Retinal fundus photograph: 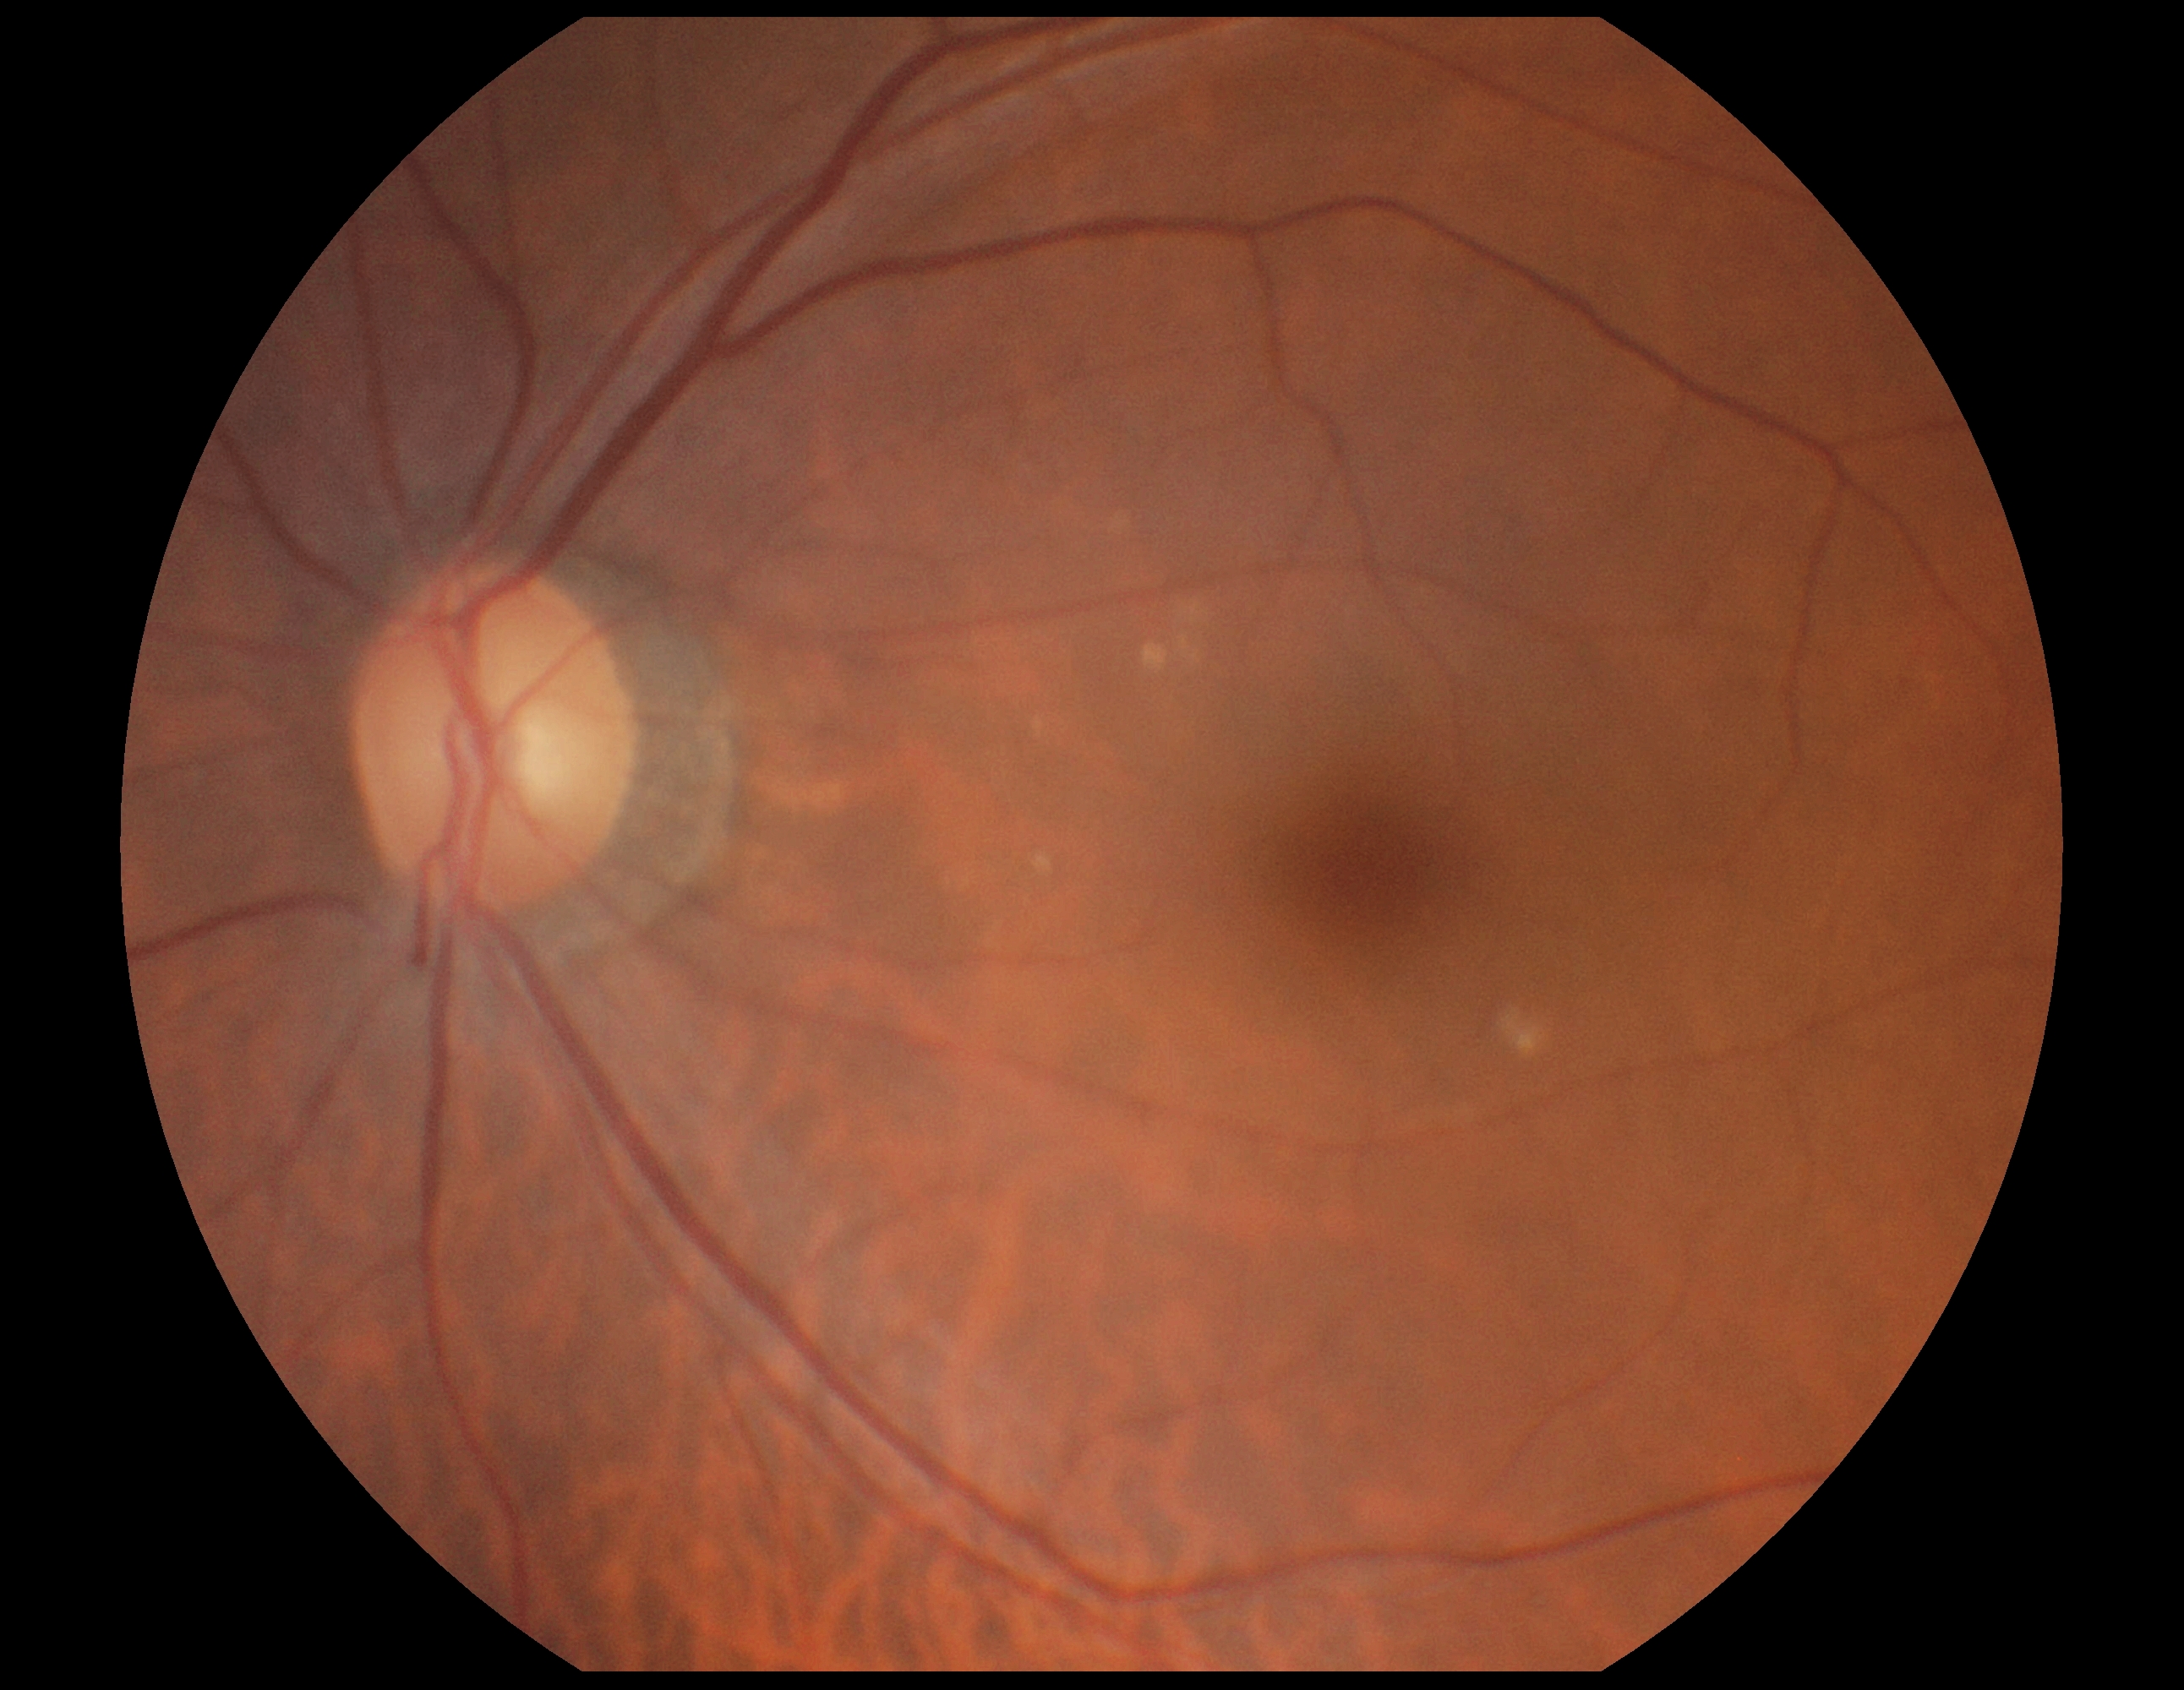 Diabetic retinopathy severity is 0/4.